1932x1910; 45° FOV; color fundus image.
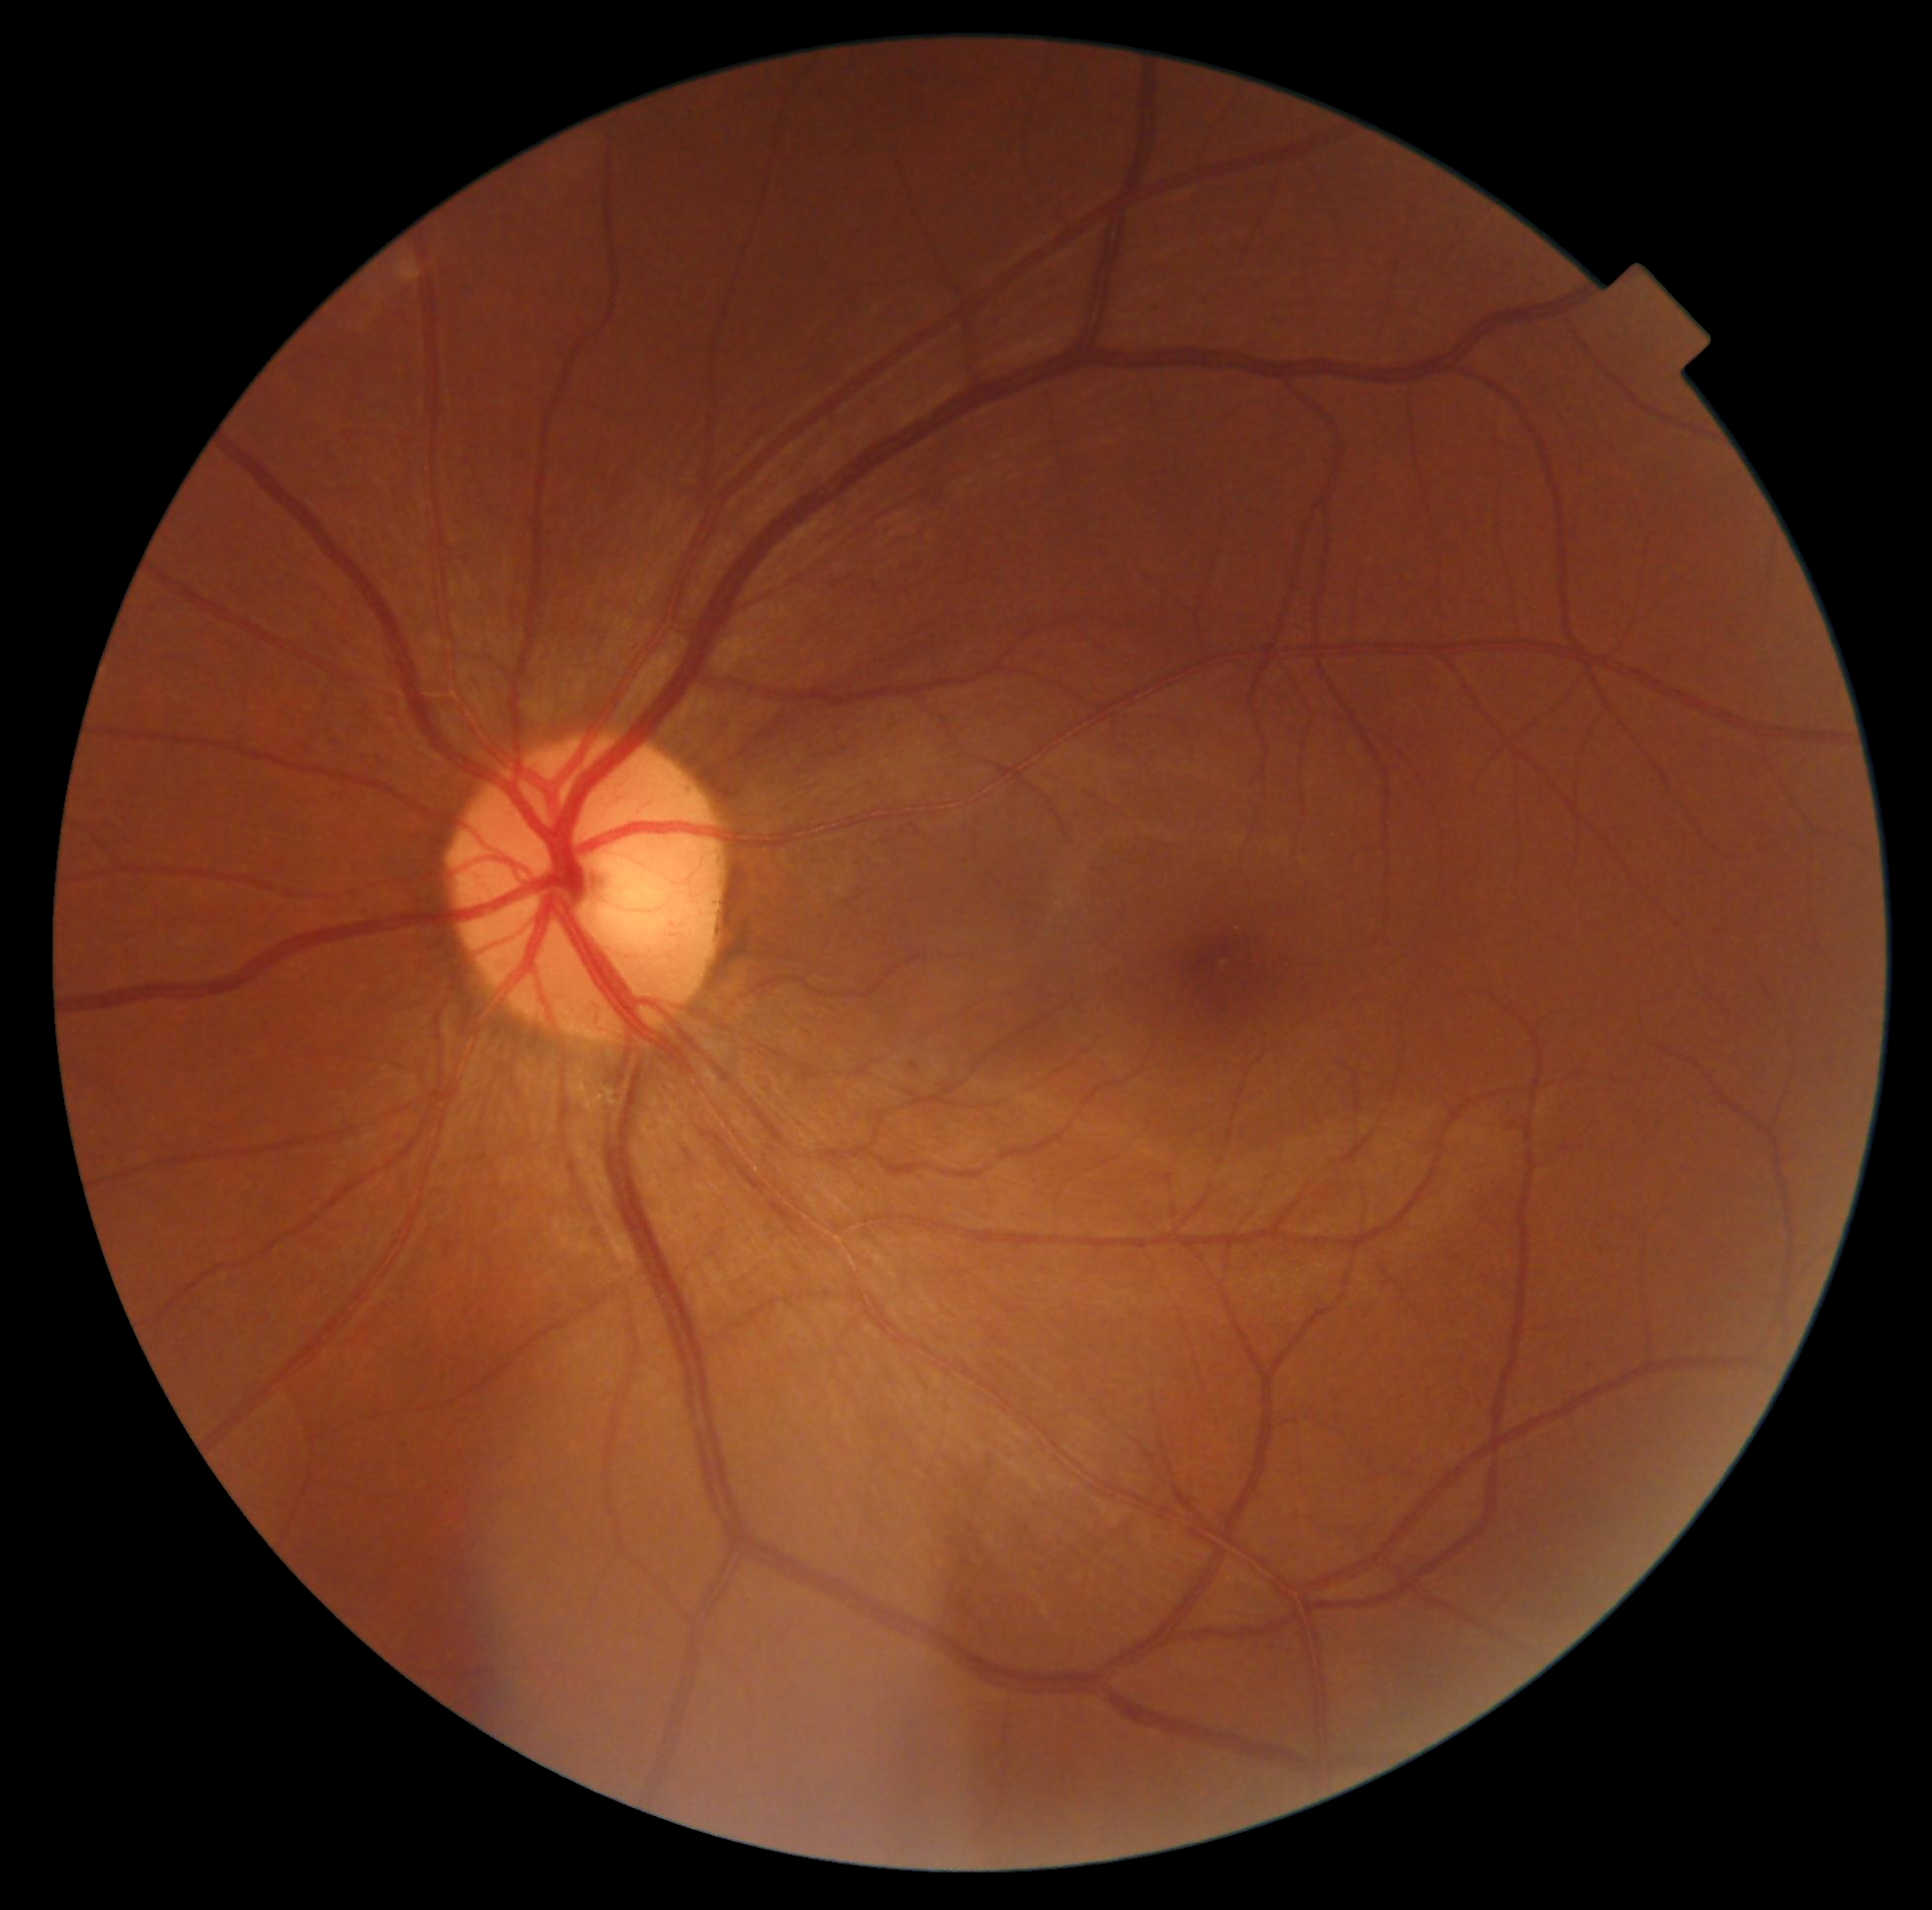 DR impression=negative for DR; diabetic retinopathy=0.